RetCam wide-field infant fundus image:
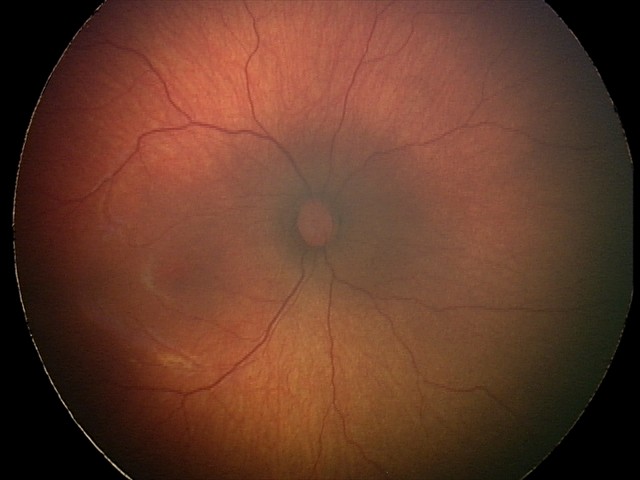
Series diagnosed as status post retinopathy of prematurity (ROP). Without plus disease.